Image size 2048x1536:
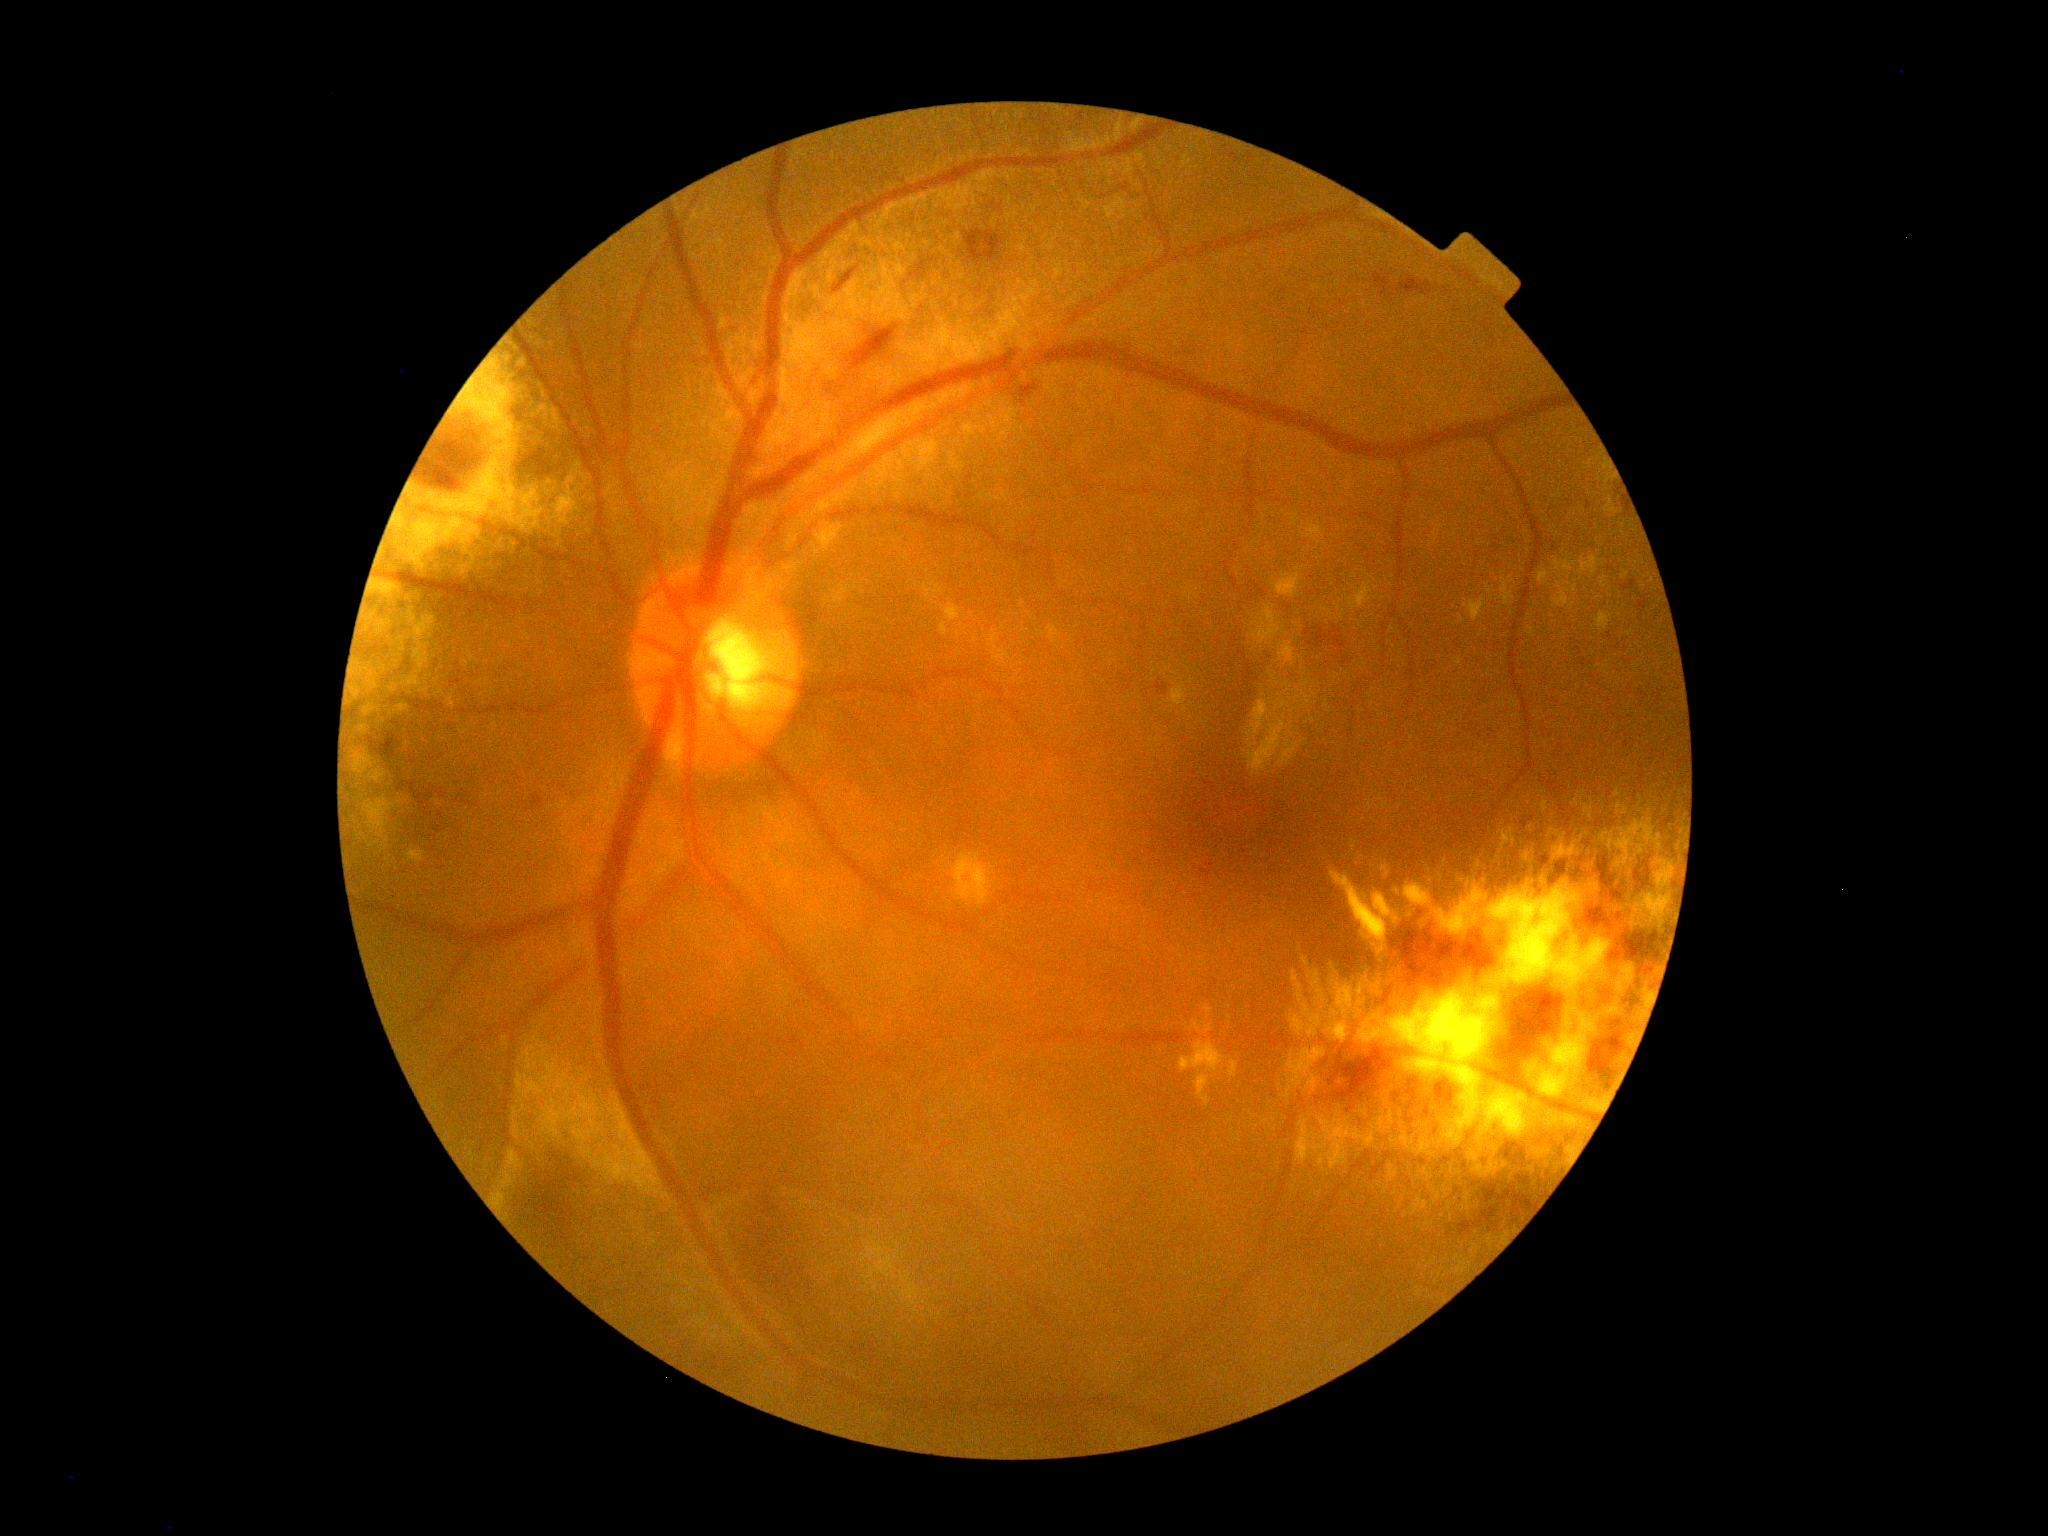 {"dr_grade": "grade 2 (moderate NPDR)", "dr_category": "non-proliferative diabetic retinopathy"}